Color fundus image · 2352x1568:
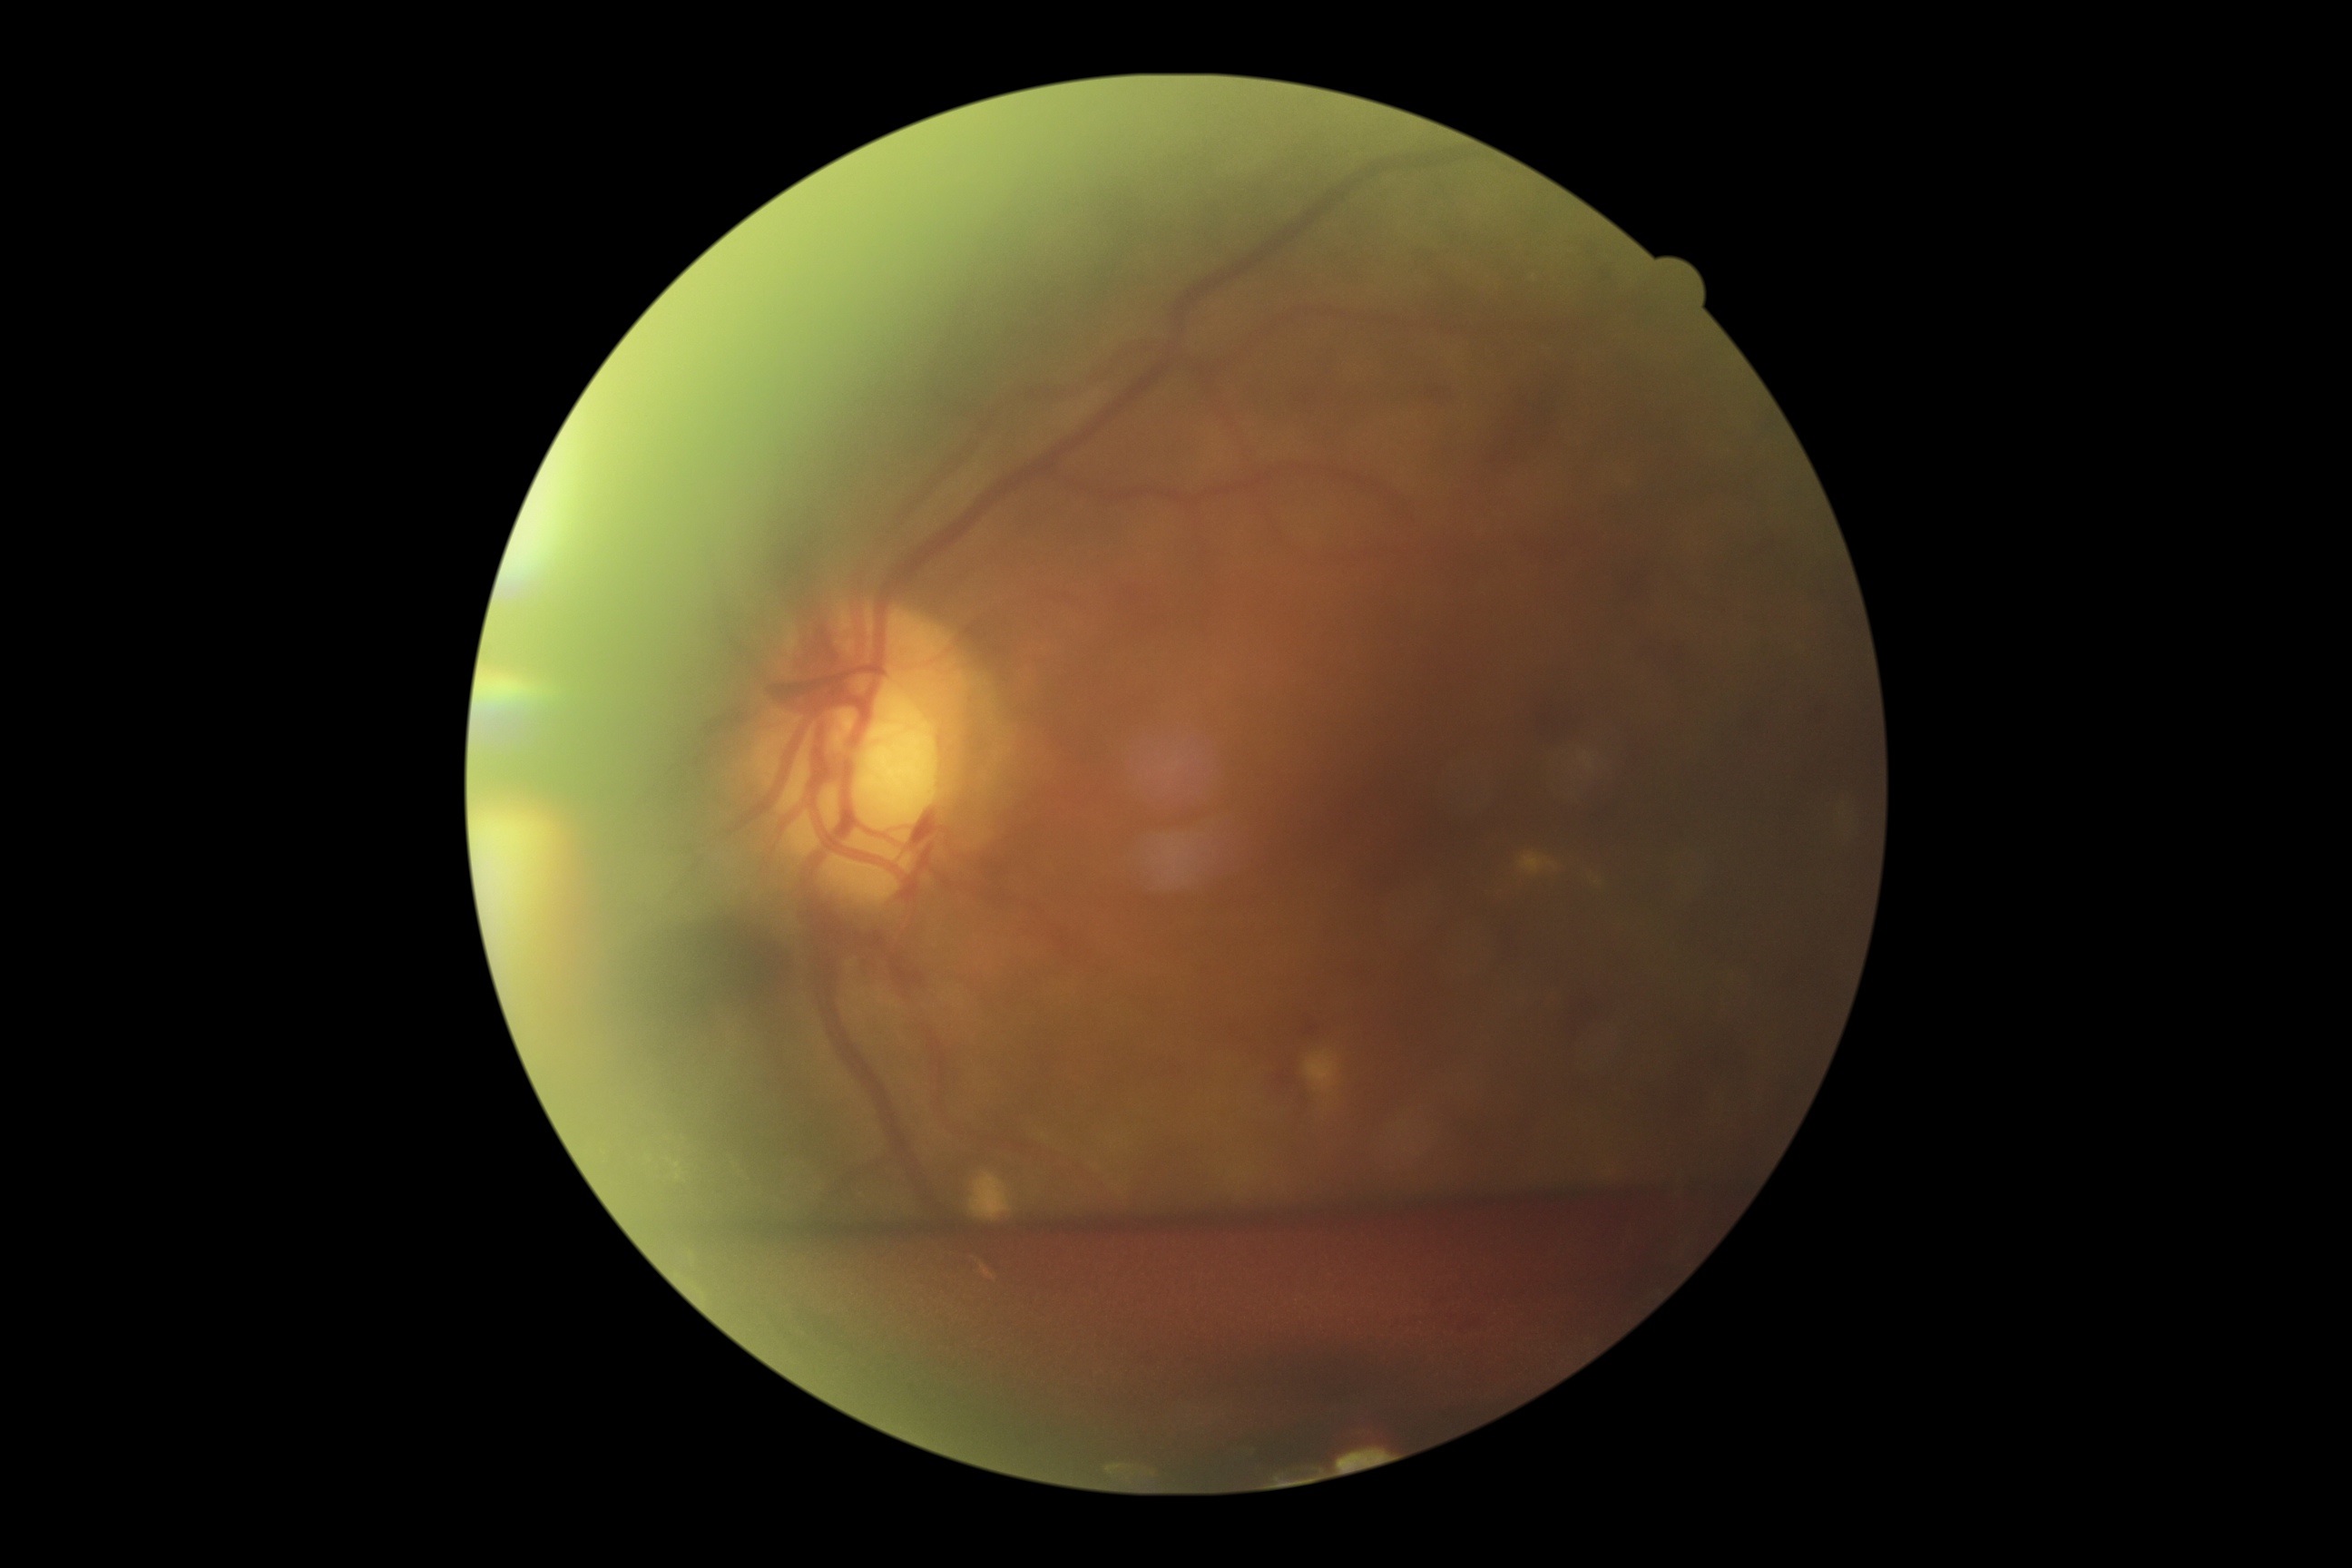

dr_grade: proliferative diabetic retinopathy (grade 4)